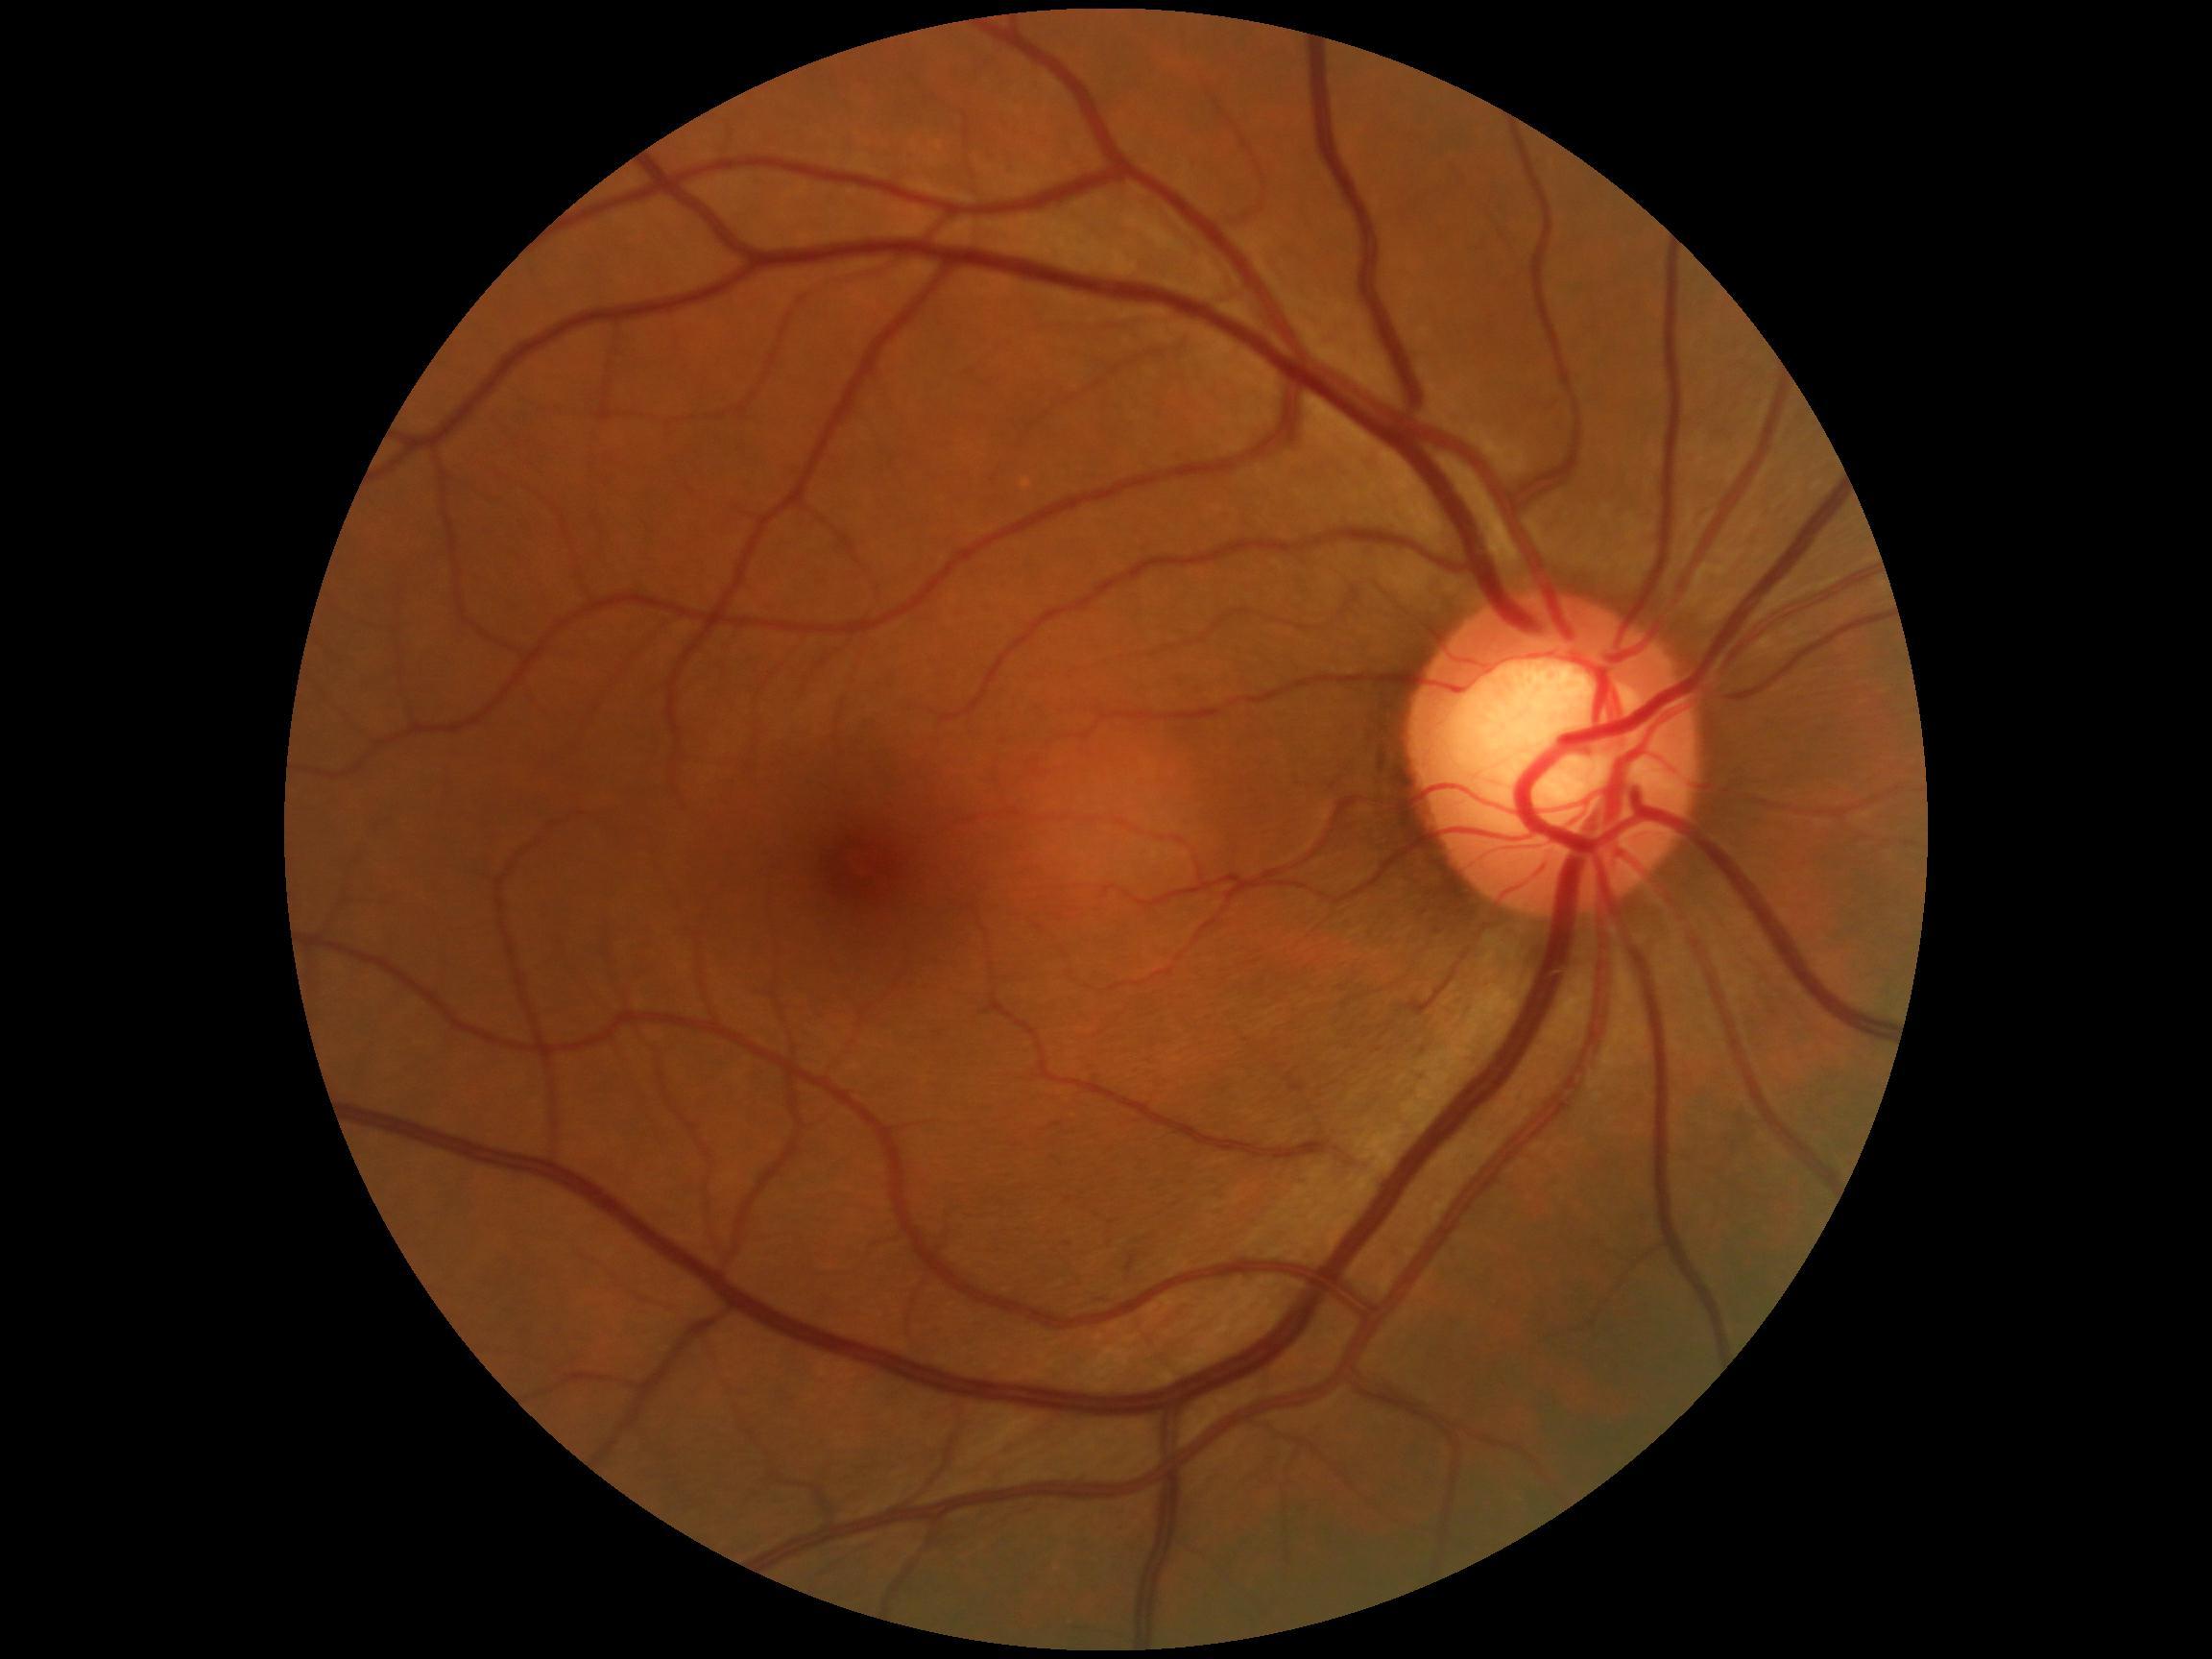 DR impression = no signs of DR, diabetic retinopathy severity = no apparent diabetic retinopathy (grade 0).